Remidio Fundus on Phone:
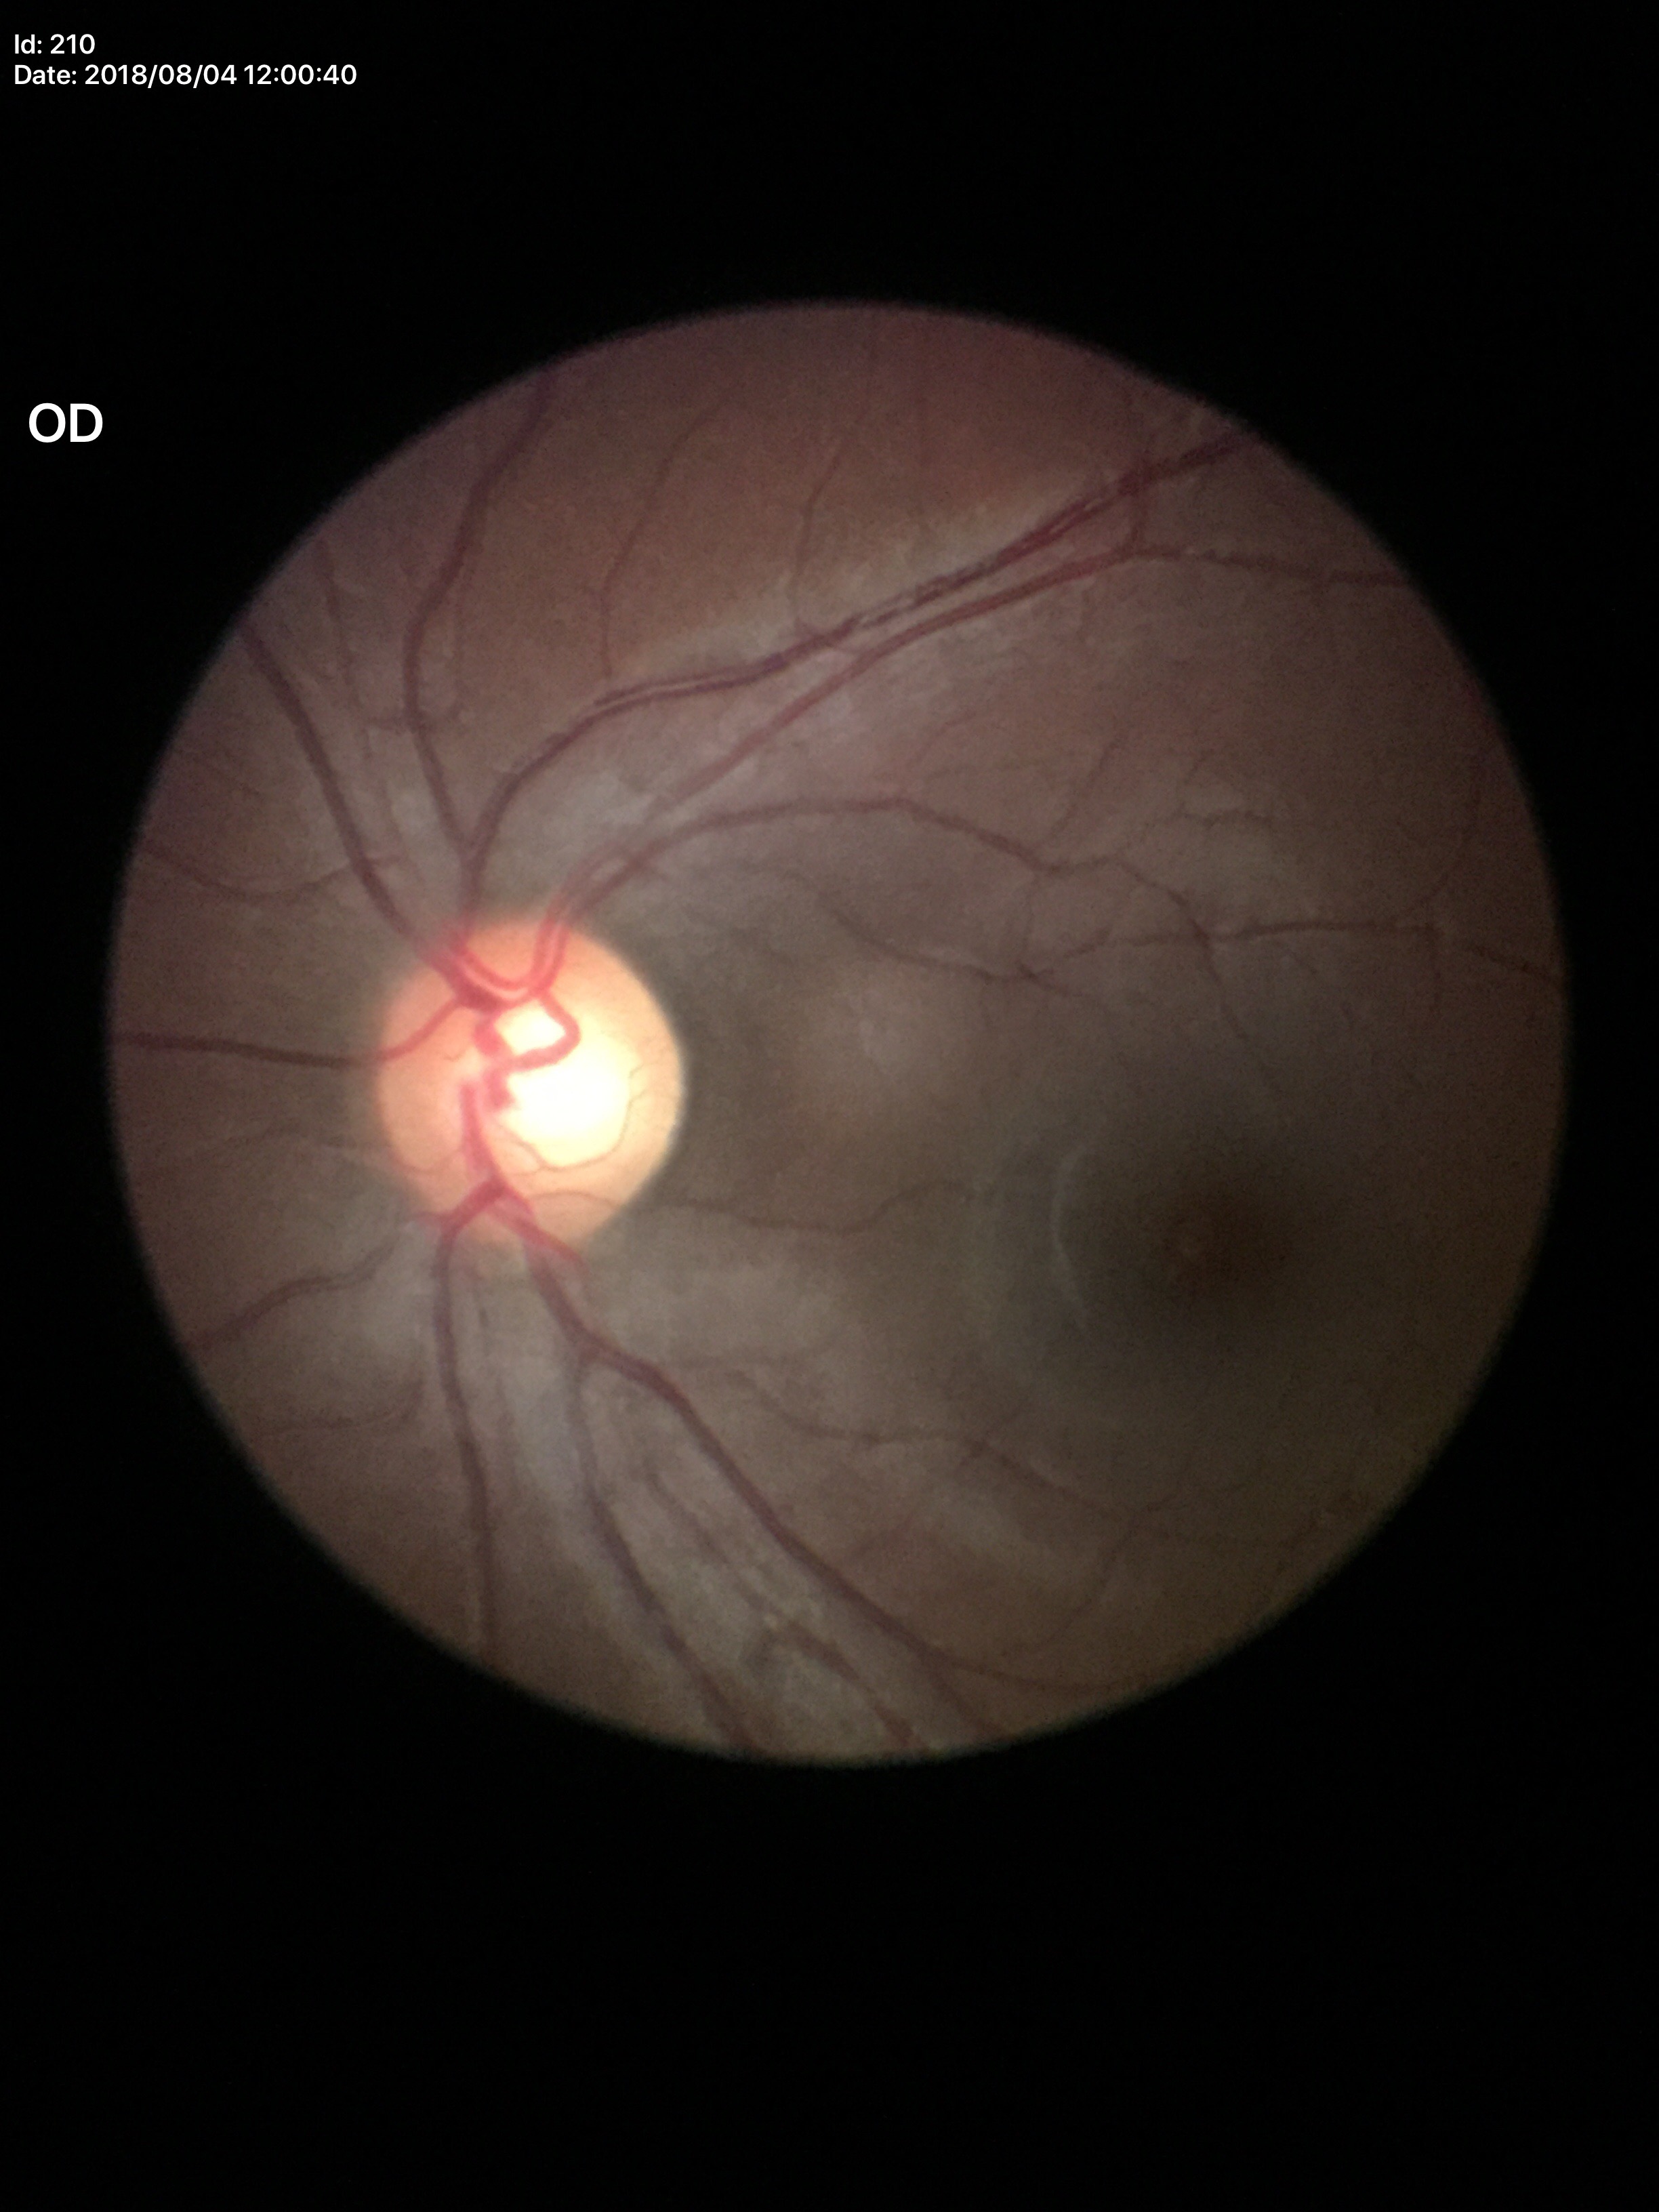

glaucoma_decision: suspicious findings (3 of 5 graders flagged glaucoma suspect)
vcdr: 0.66
hcdr: 0.64